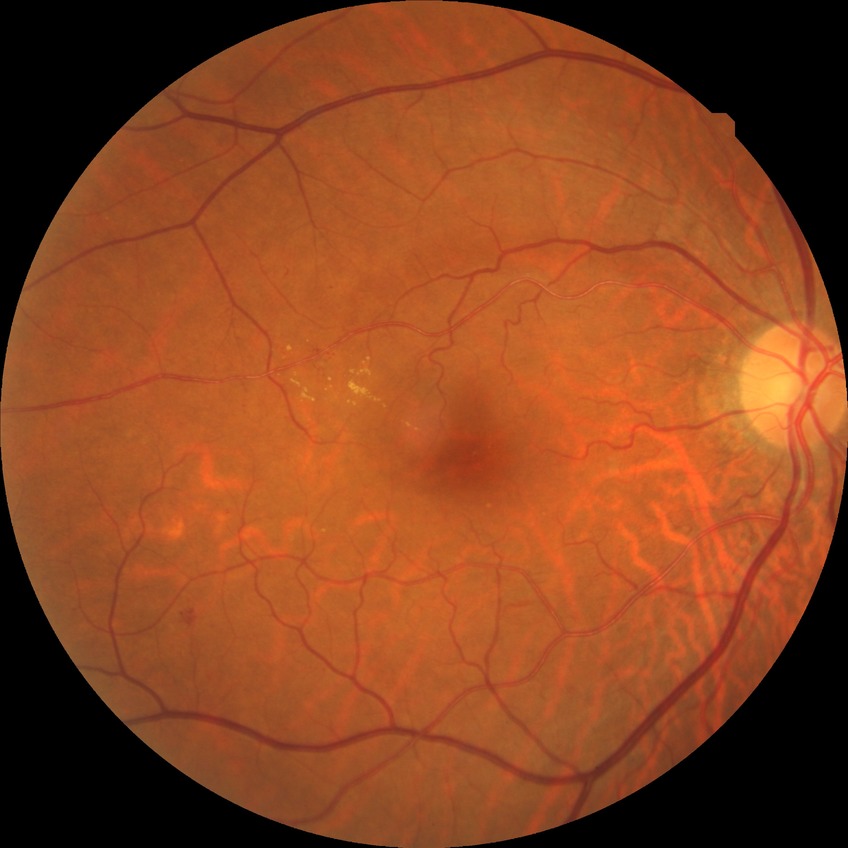 diabetic retinopathy stage: simple diabetic retinopathy.